640x480px; acquired on the Clarity RetCam 3; RetCam wide-field infant fundus image: 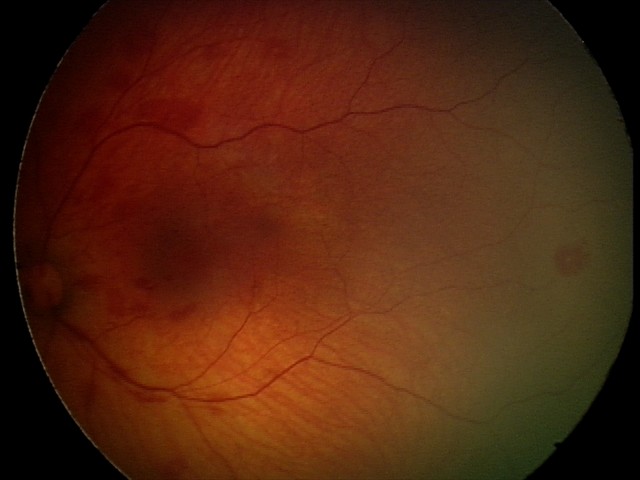 Screening series with retinal hemorrhages.